Modified Davis classification — 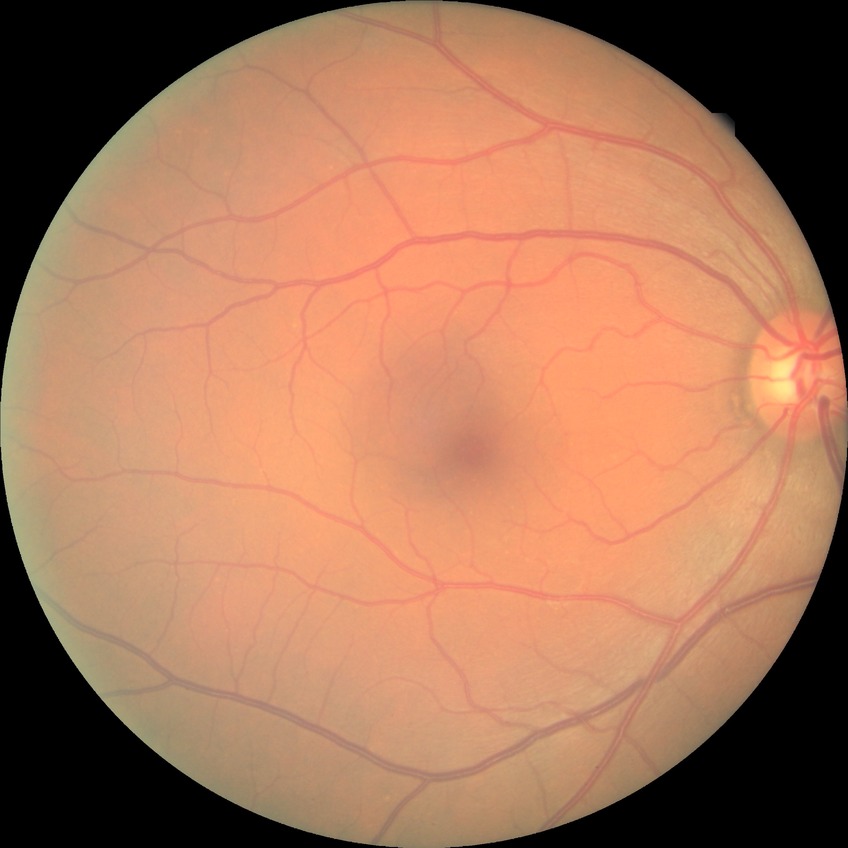

Diabetic retinopathy (DR): NDR (no diabetic retinopathy).